Pediatric retinal photograph (wide-field) — 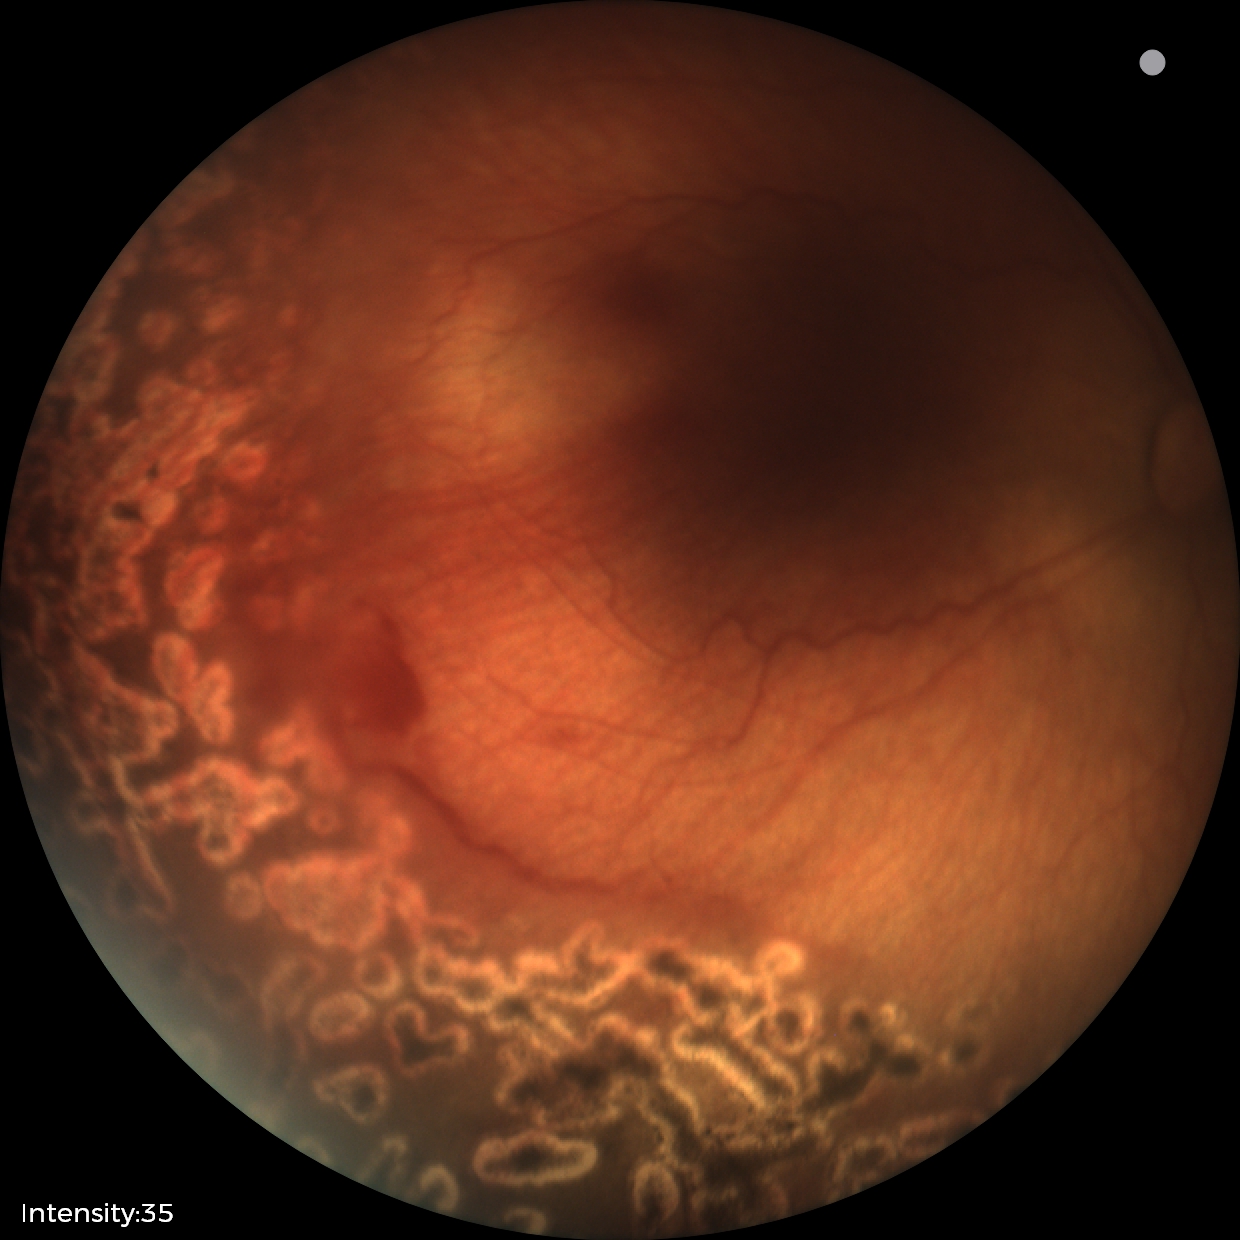 Assessment: status post ROP.